Optic disc photograph: 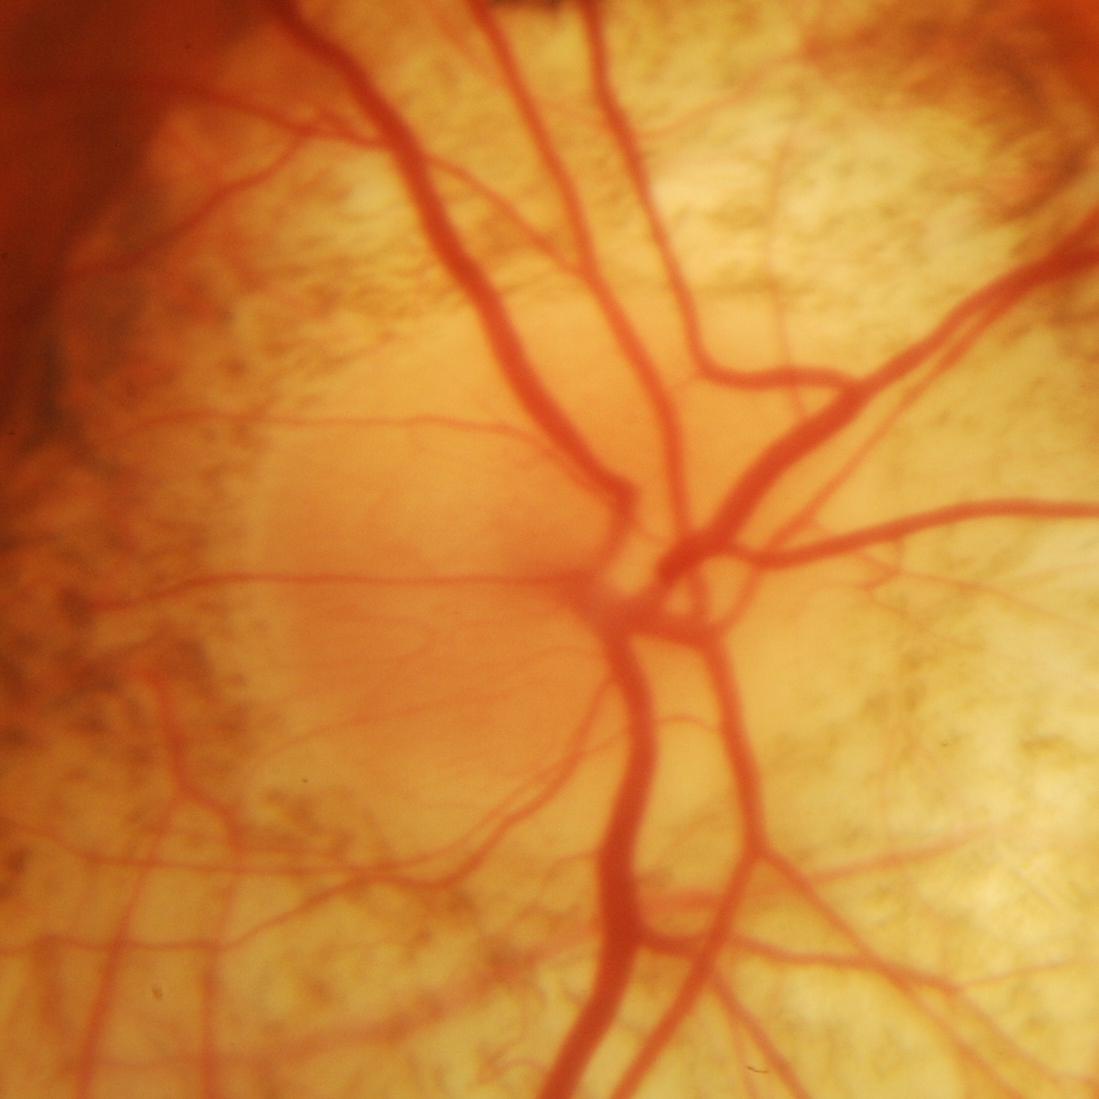

Glaucoma is present. Finding: evidence of glaucoma.